Wide-field fundus image from infant ROP screening · 640 x 480 pixels · Clarity RetCam 3, 130° FOV: 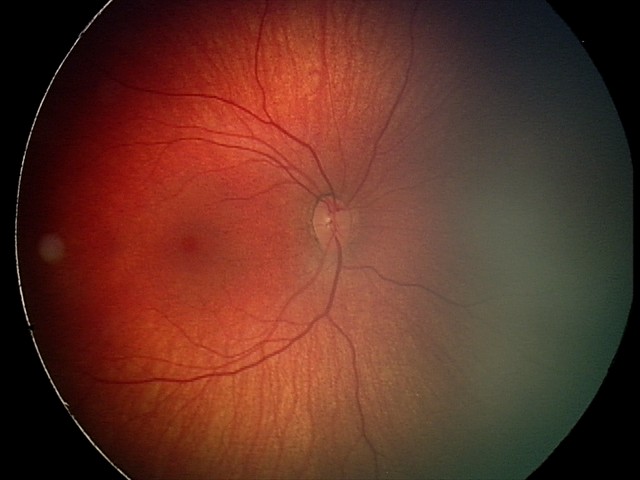

Screening examination consistent with retinal hemorrhages.